1440 x 1080 pixels; infant wide-field fundus photograph
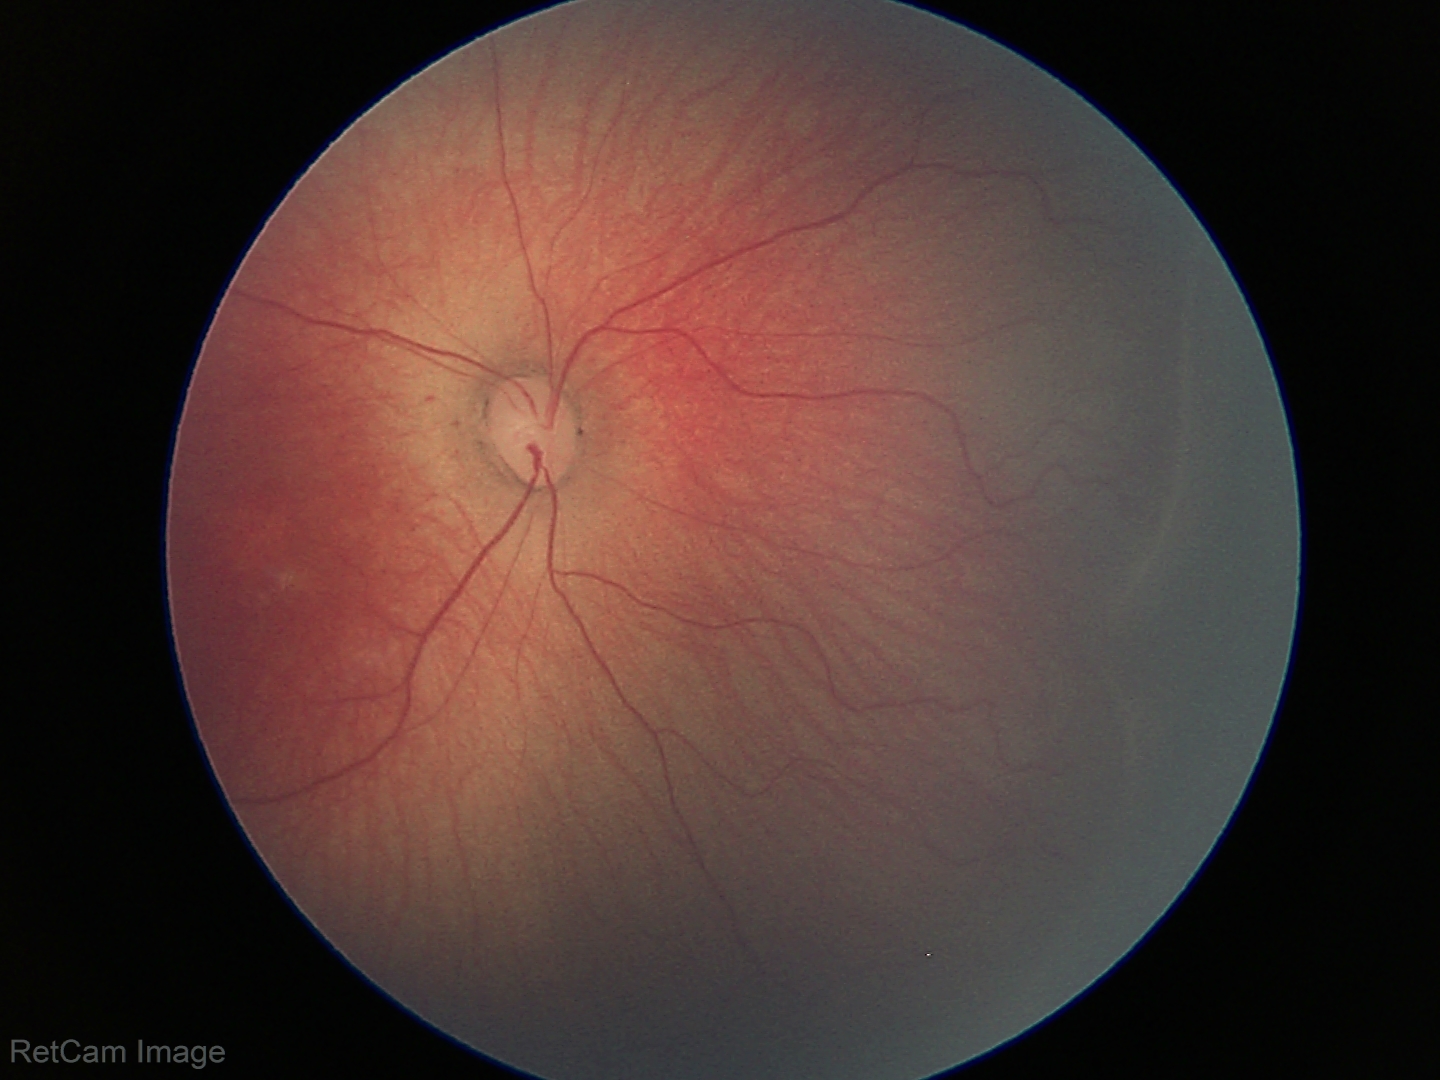

Screening examination consistent with ROP stage 1.